Color fundus photograph — 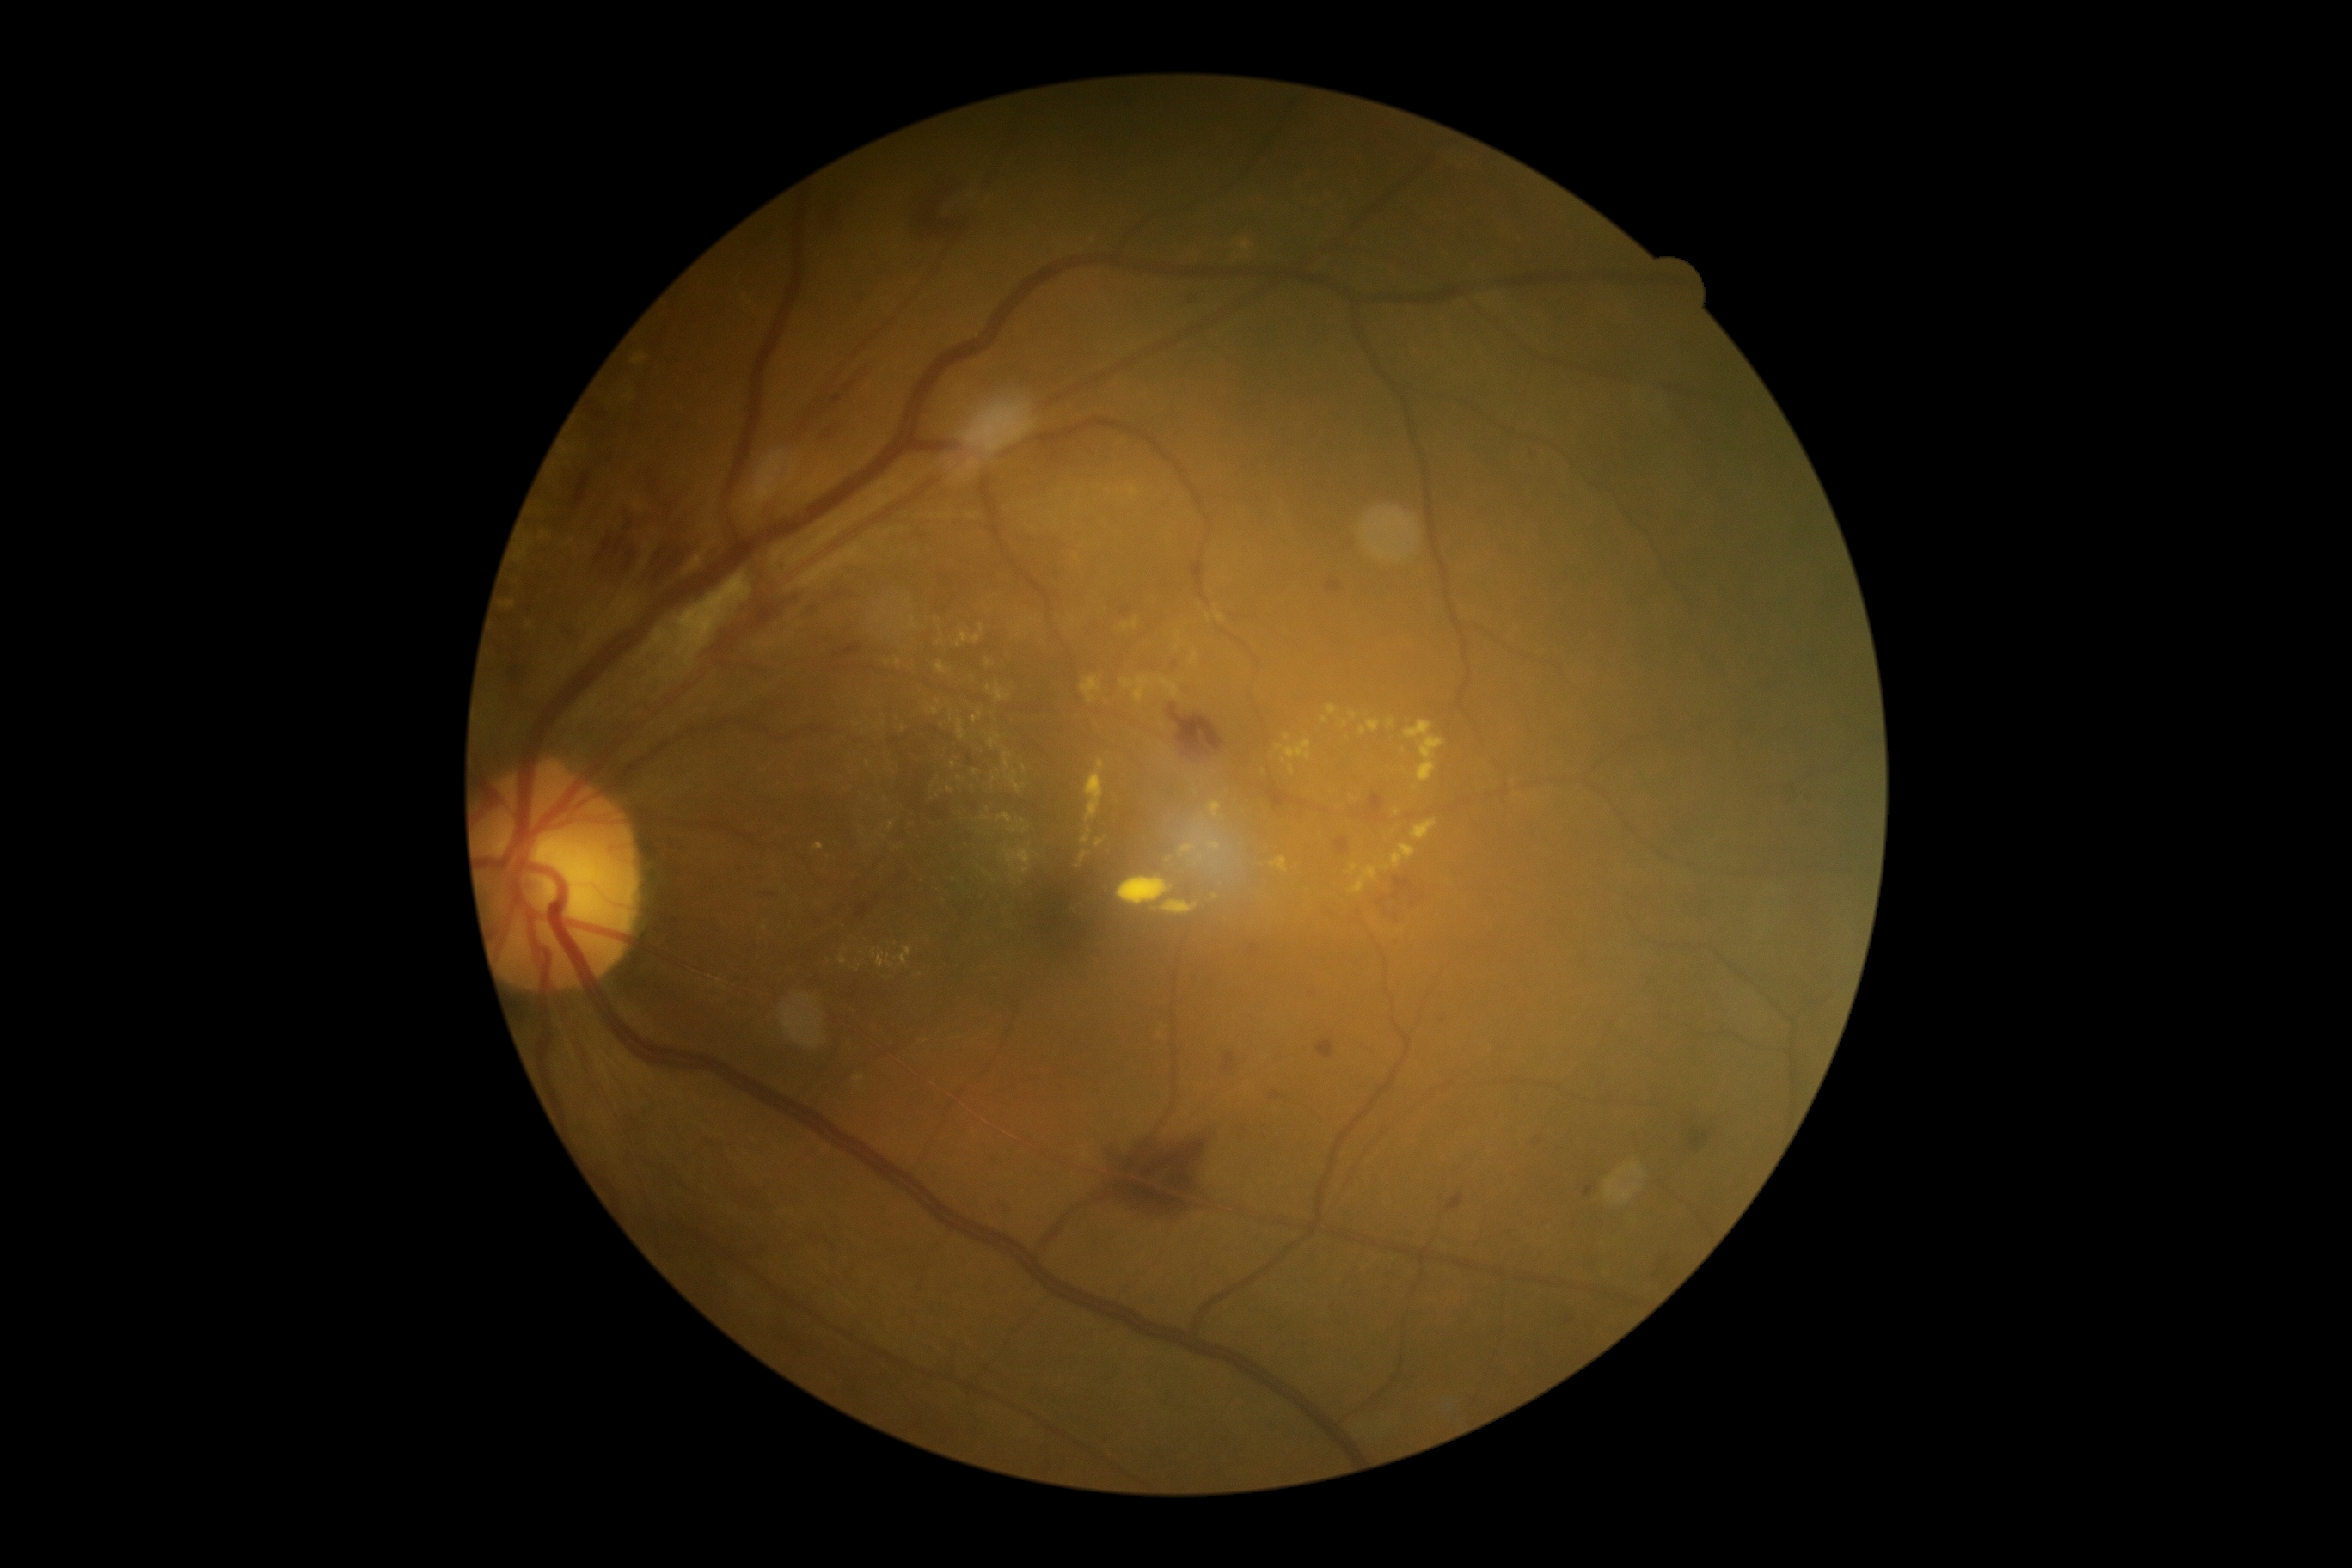

Retinopathy grade is moderate non-proliferative diabetic retinopathy (2). The retinopathy is classified as non-proliferative diabetic retinopathy.